45 degree fundus photograph:
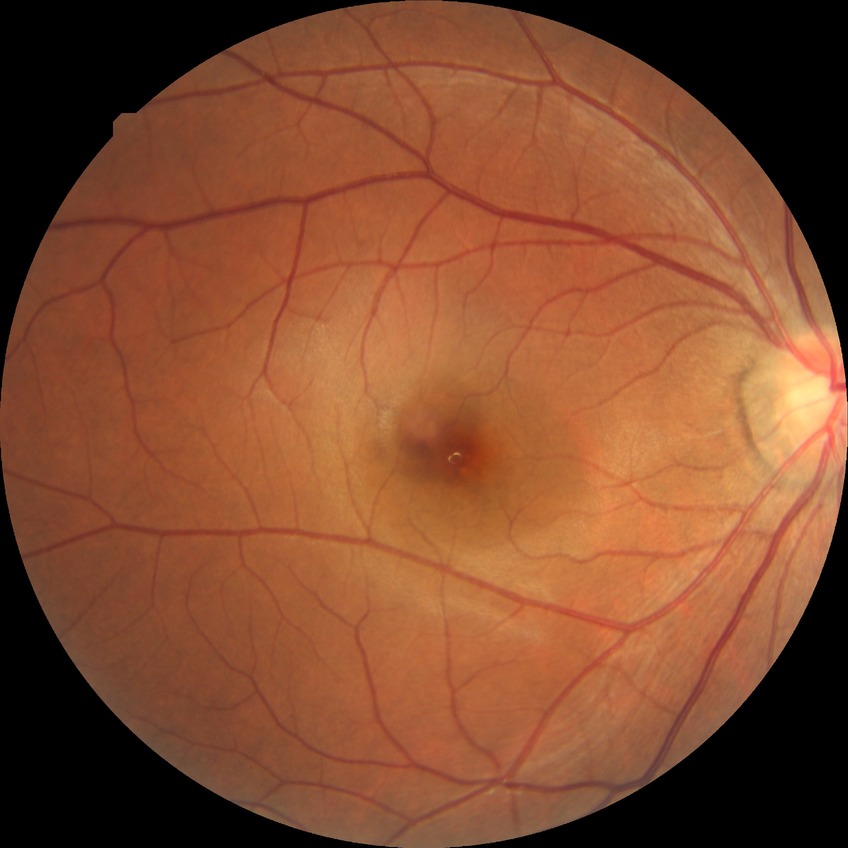

retinopathy stage = no diabetic retinopathy.